1659 x 2212 pixels
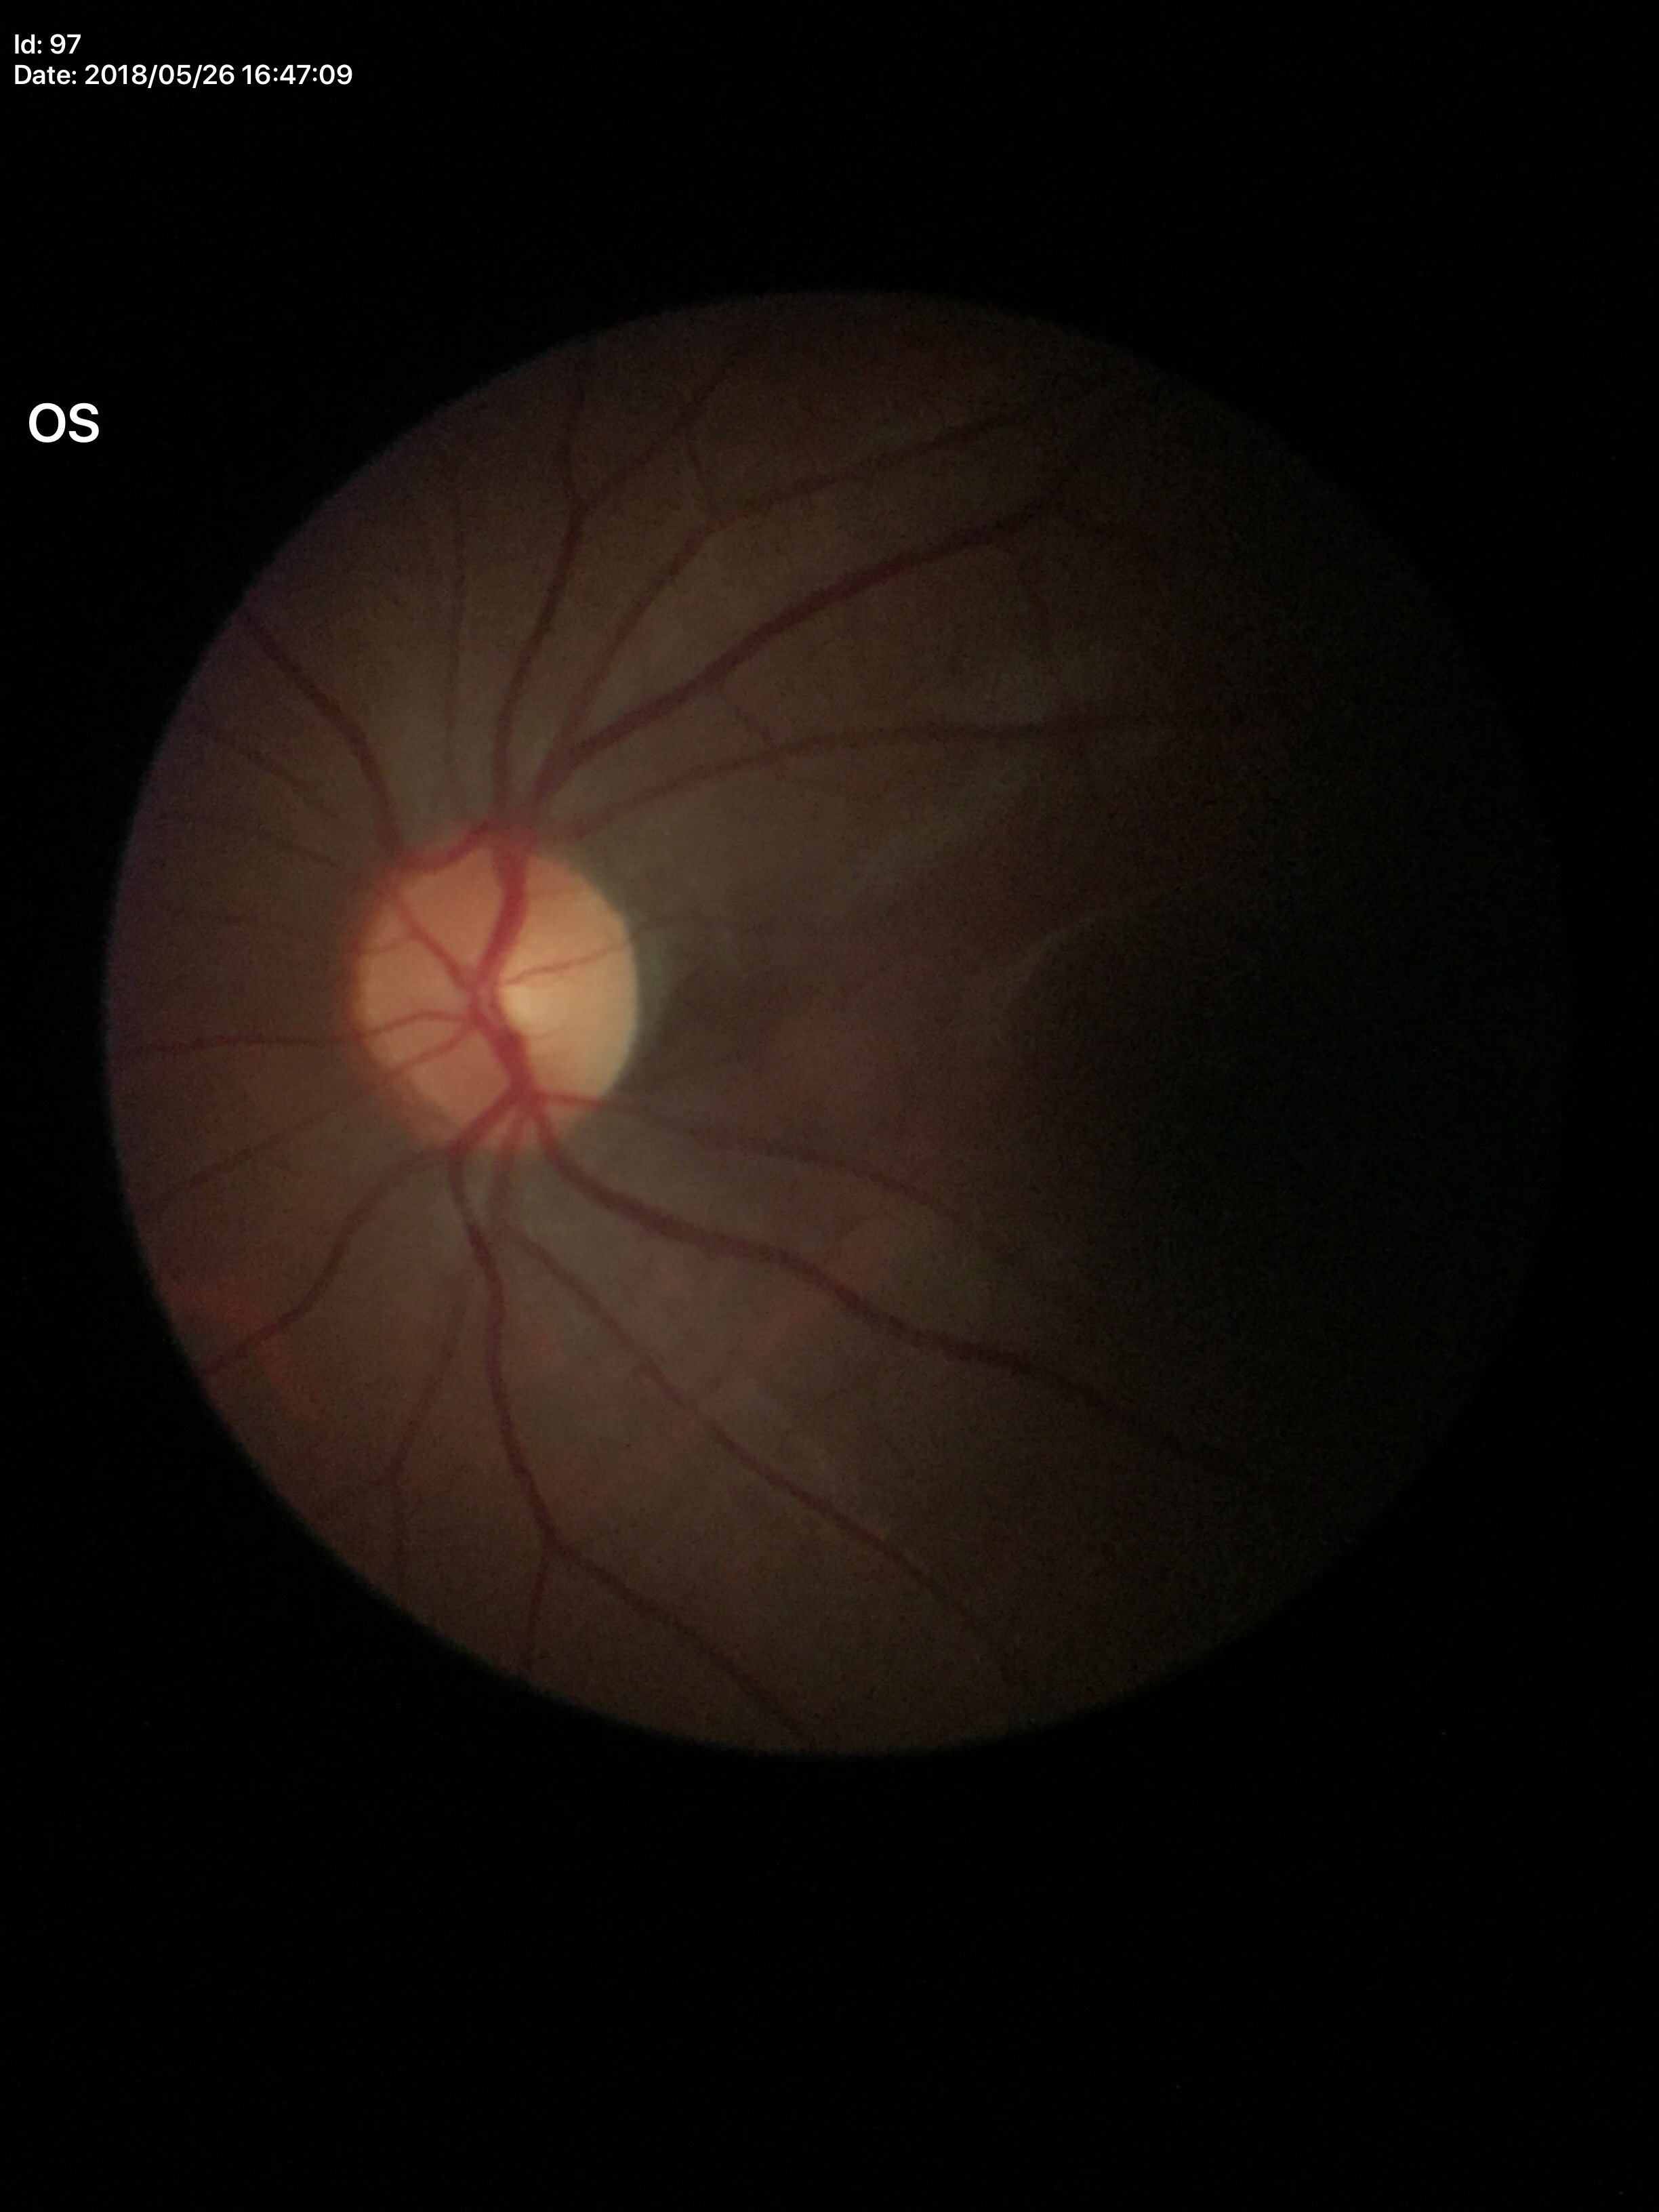
Glaucoma screening = no suspicious findings (all 5 graders called normal)
vertical CDR = 0.45